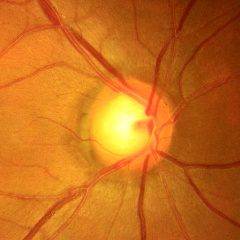 Fundus appearance consistent with no glaucomatous findings.